Image size 848x848; FOV: 45 degrees; CFP: 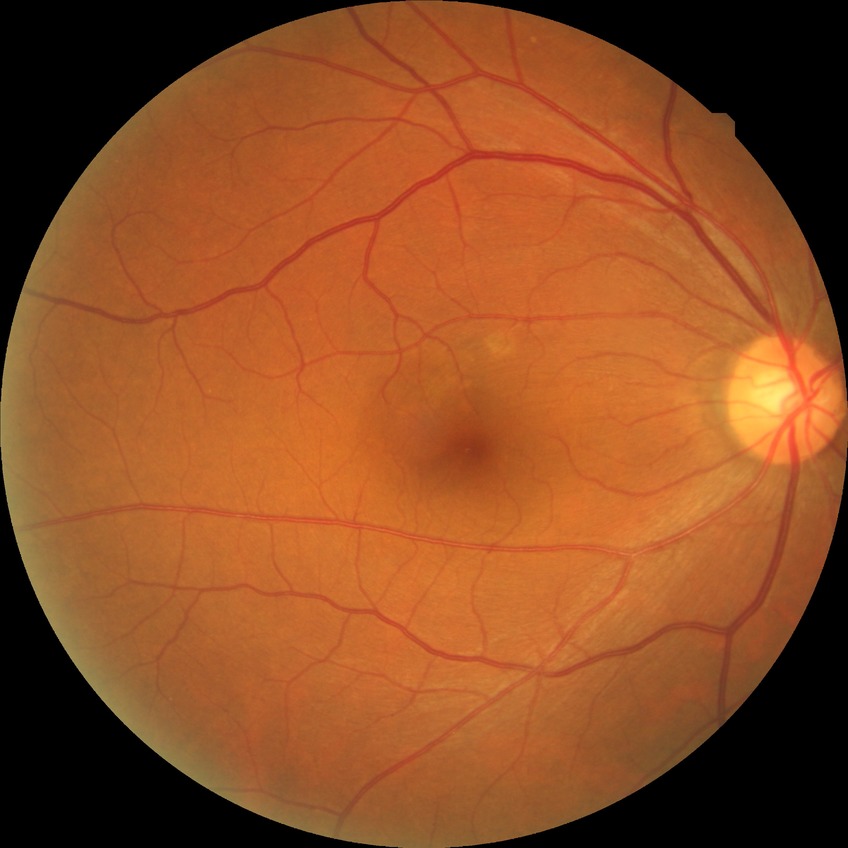 Diabetic retinopathy (DR) is NDR (no diabetic retinopathy).